45-degree field of view:
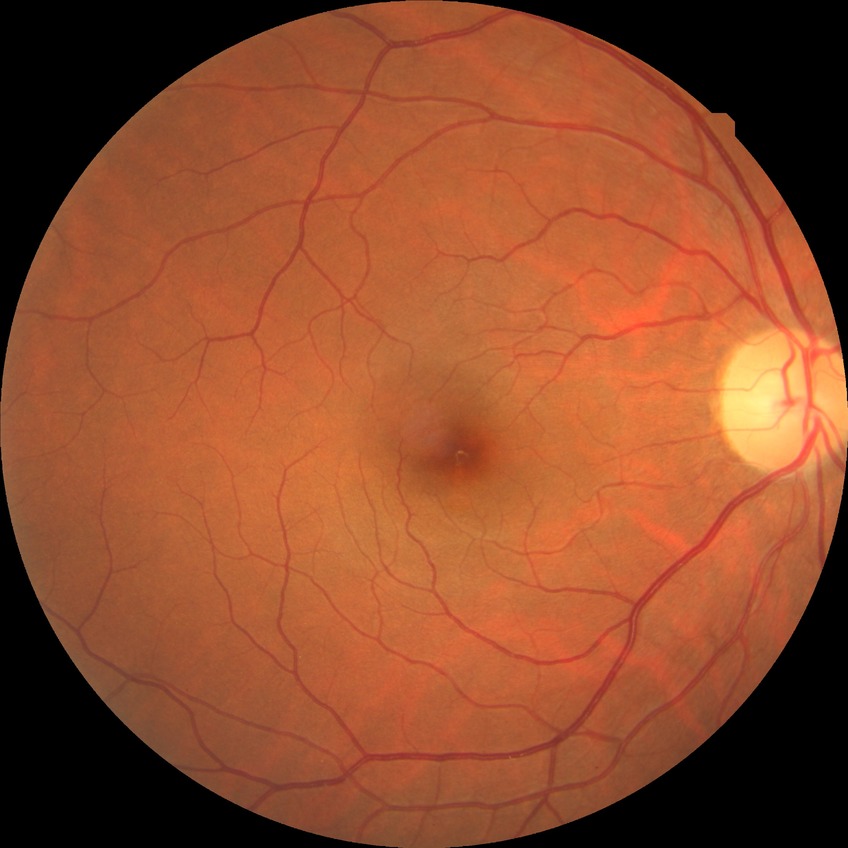 davis_grade: no diabetic retinopathy